130° field of view (Clarity RetCam 3). Pediatric wide-field fundus photograph.
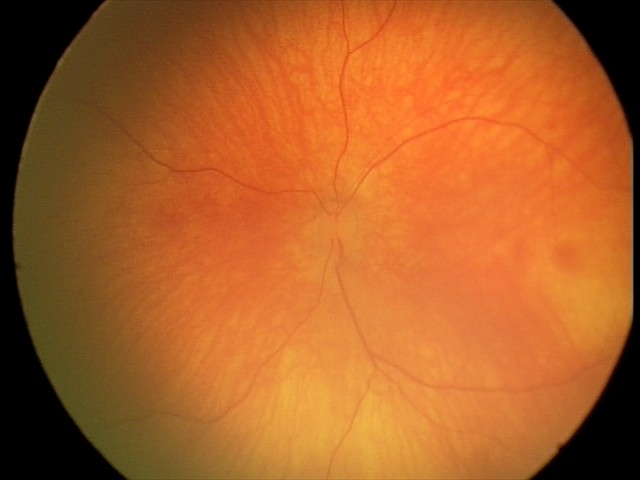
Screening examination diagnosed as physiological.